2212x1659.
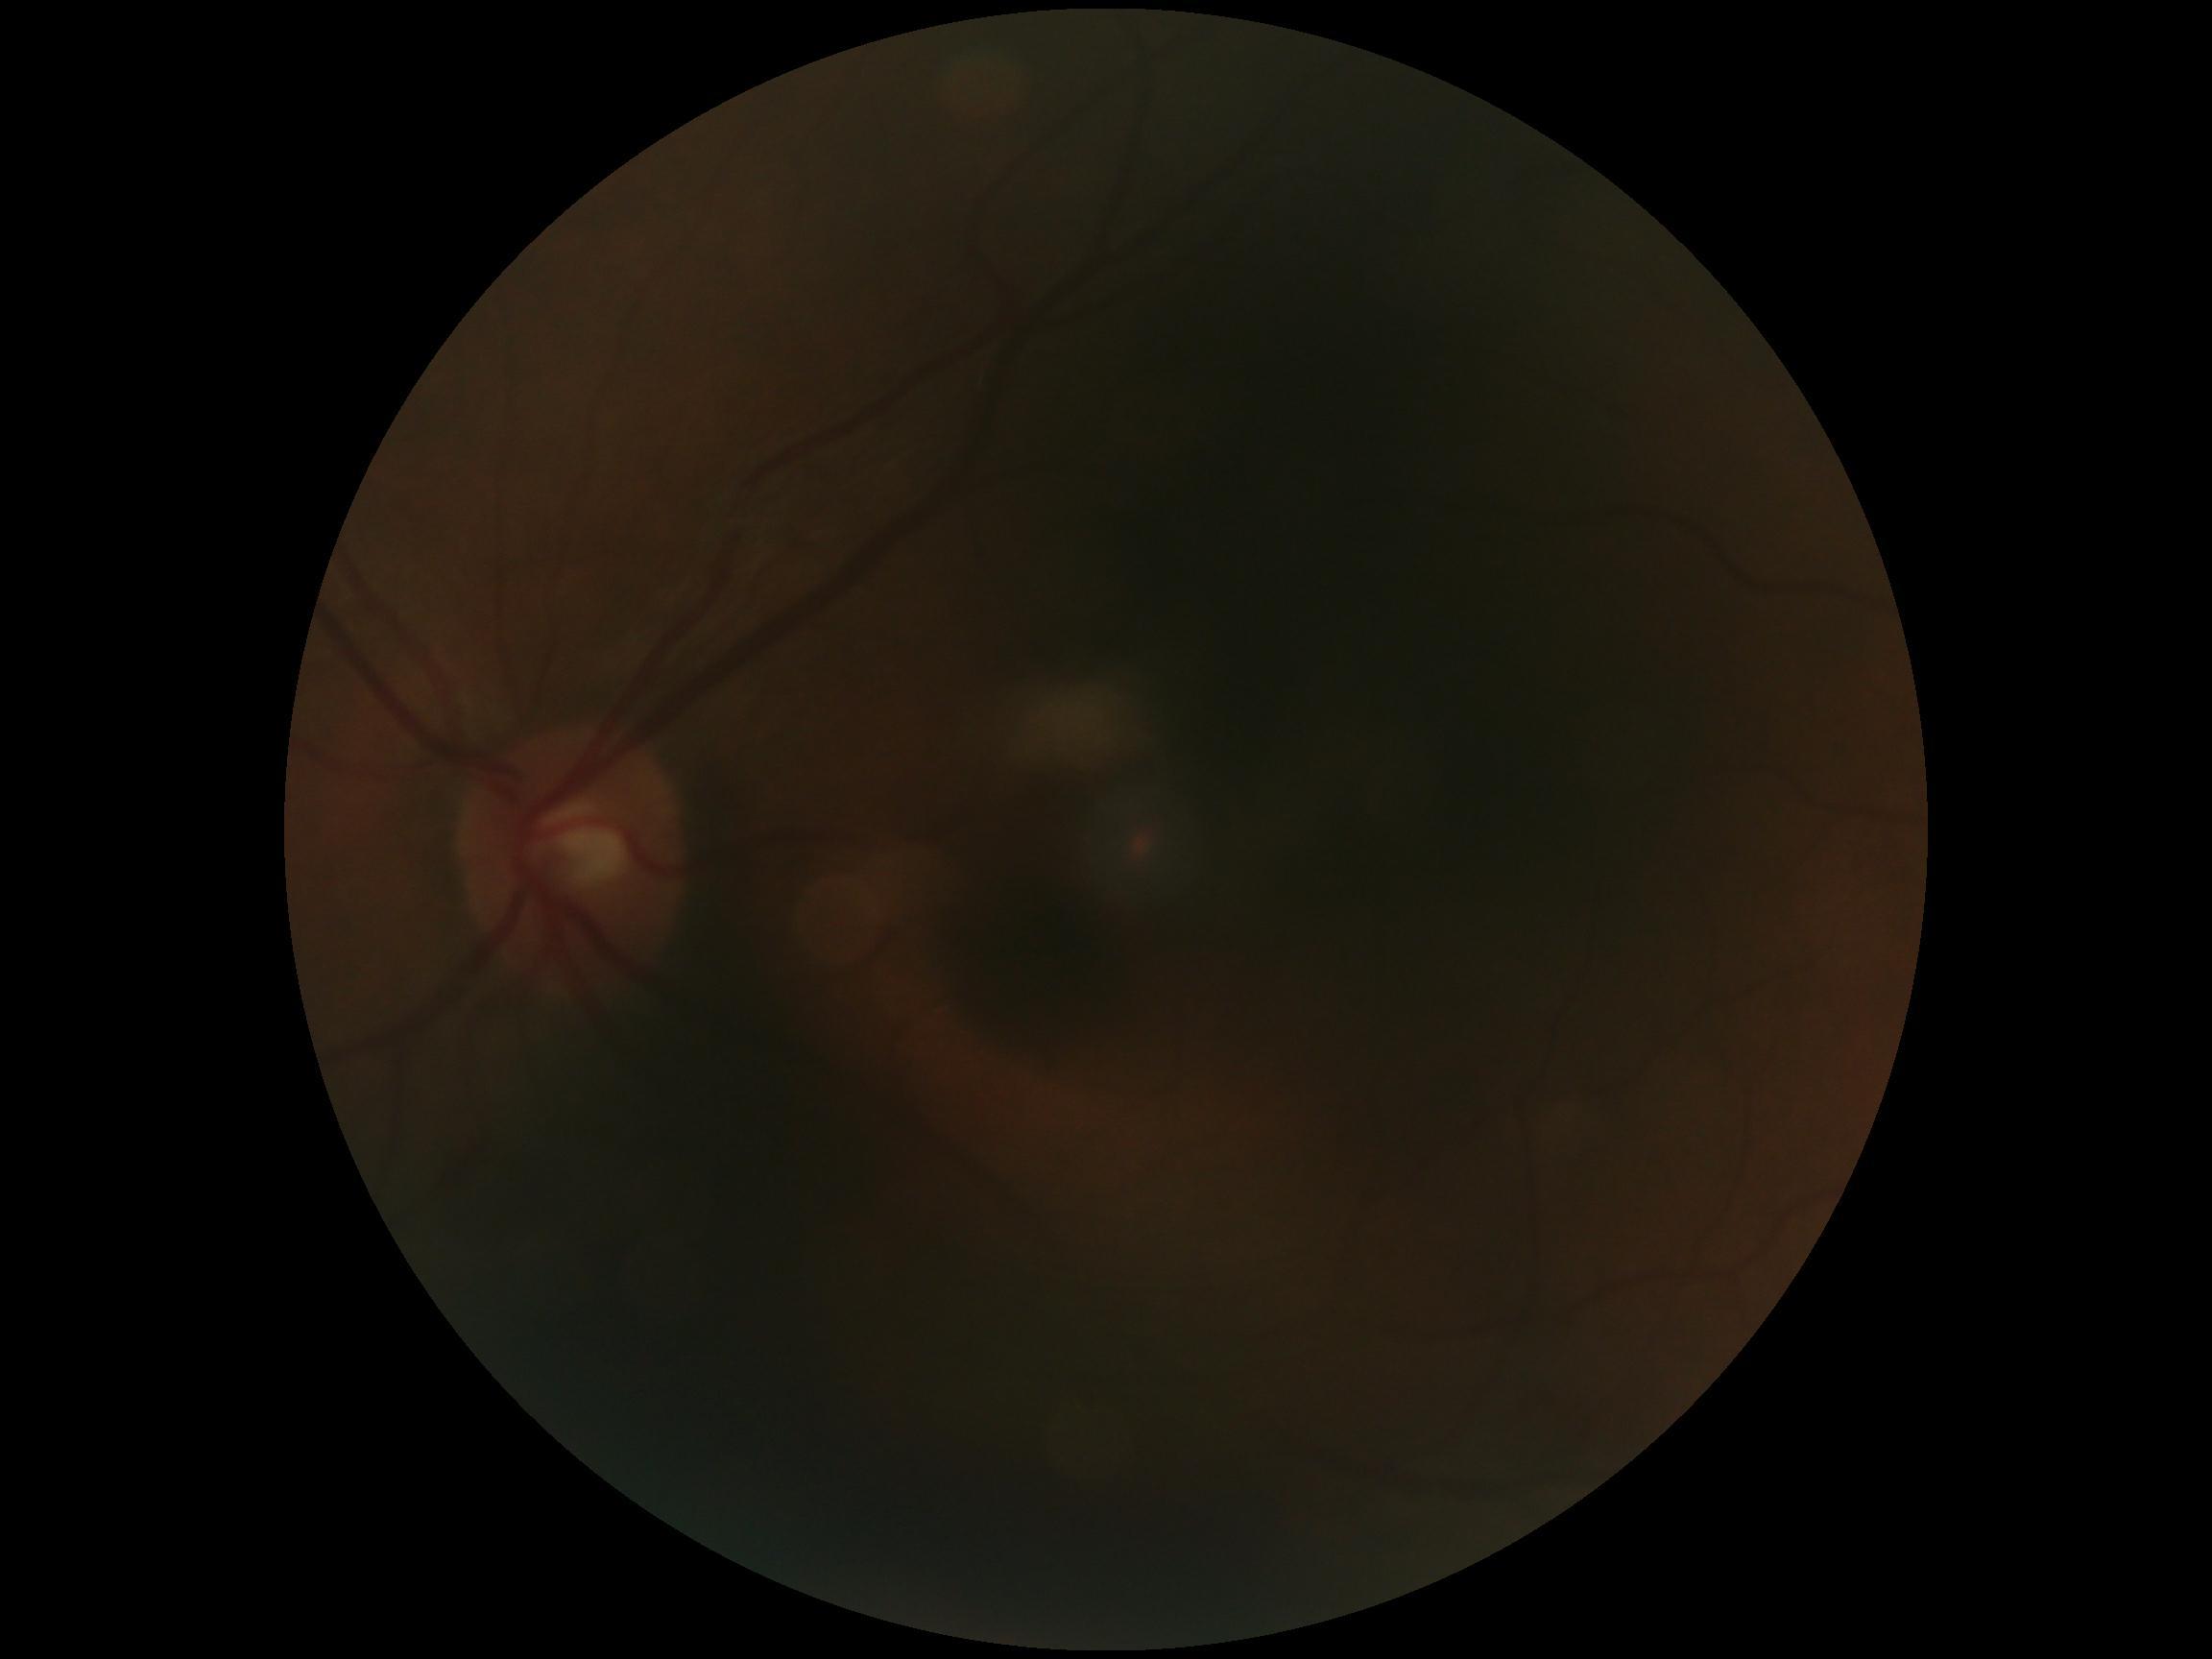

image quality = insufficient for DR assessment
retinopathy grade = ungradable